848 by 848 pixels · acquired with a NIDEK AFC-230:
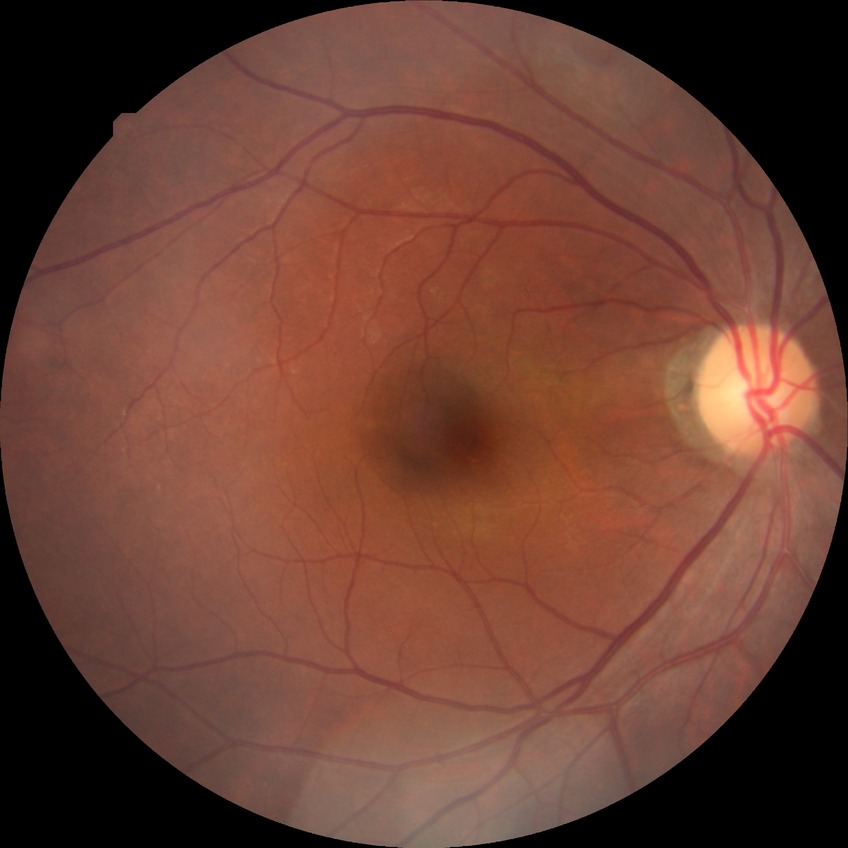
Diabetic retinopathy grade: no diabetic retinopathy.